45-degree field of view, NIDEK AFC-230 fundus camera: 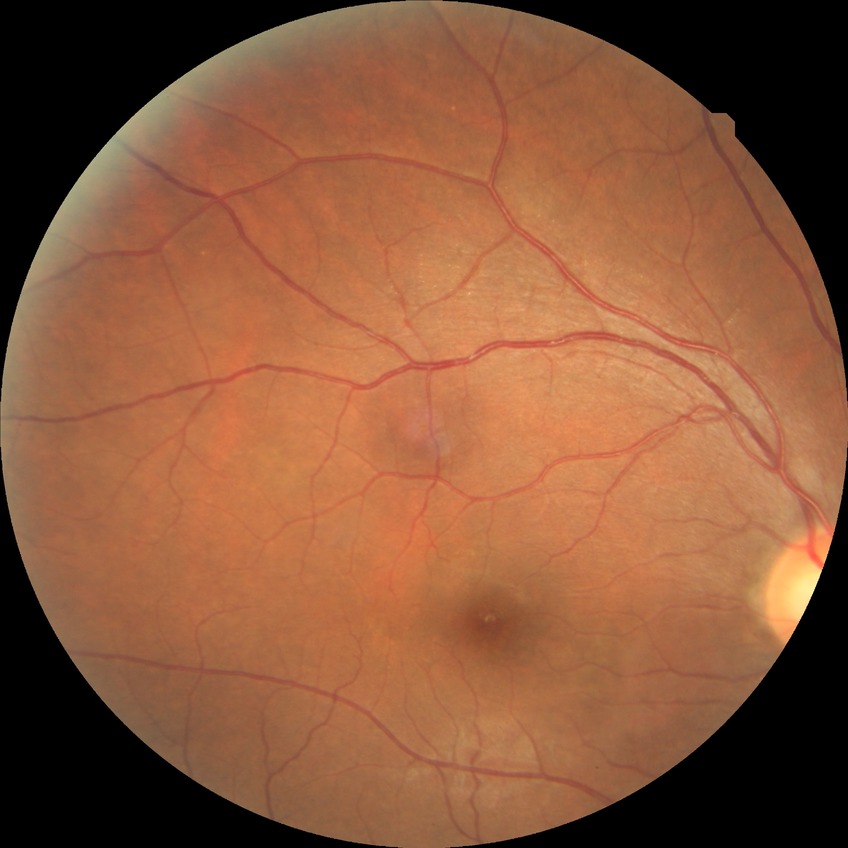
Diabetic retinopathy (DR) is no diabetic retinopathy (NDR).